848 by 848 pixels; CFP: 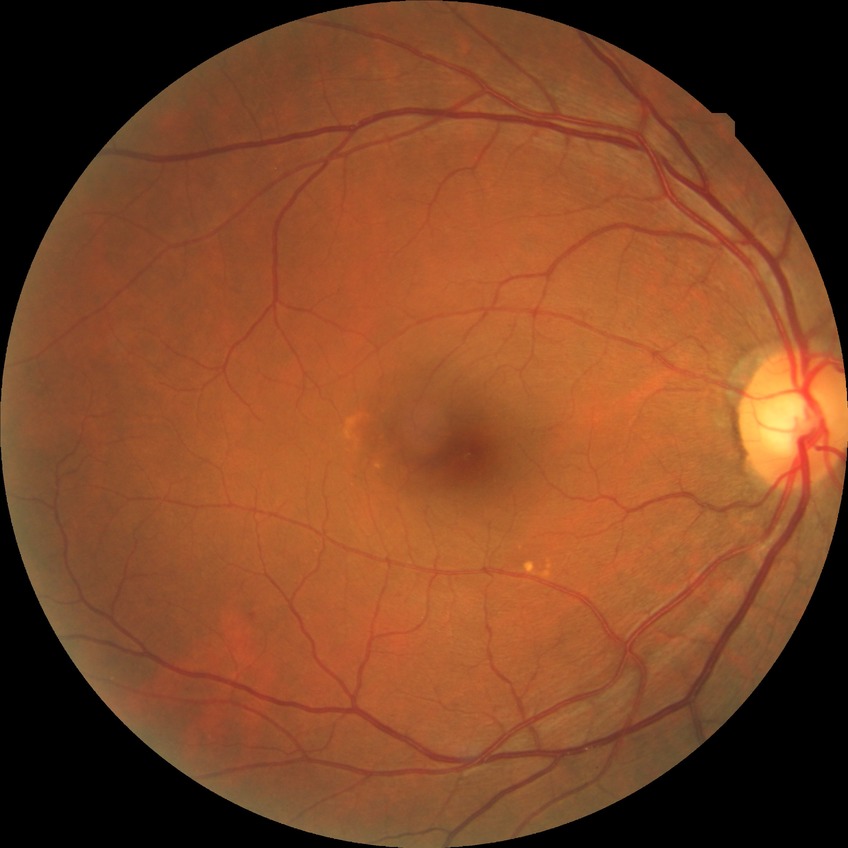 * diabetic retinopathy (DR): NDR (no diabetic retinopathy)